848x848: 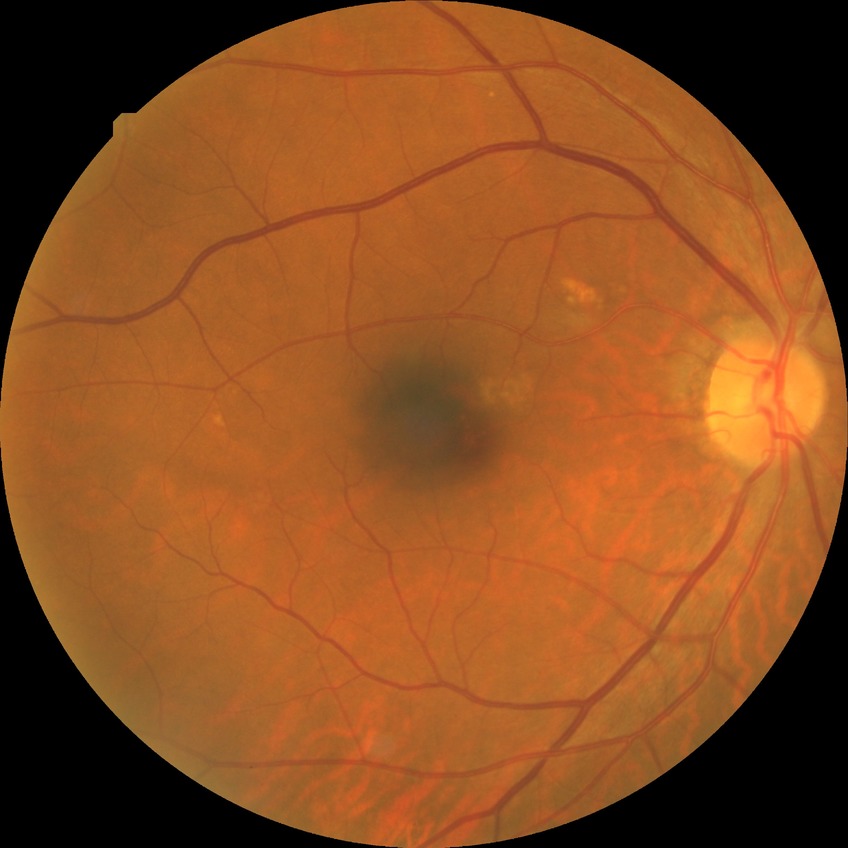

{"davis_grade": "NDR", "dr_impression": "negative for DR"}